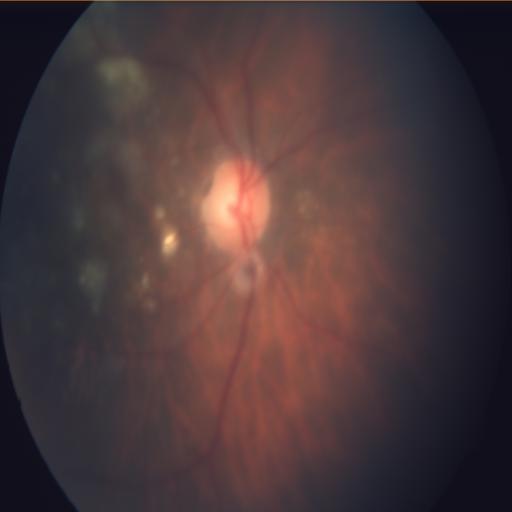

Pathology (3):
- myopia
- tessellation
- cotton wool spots